DR severity per modified Davis staging
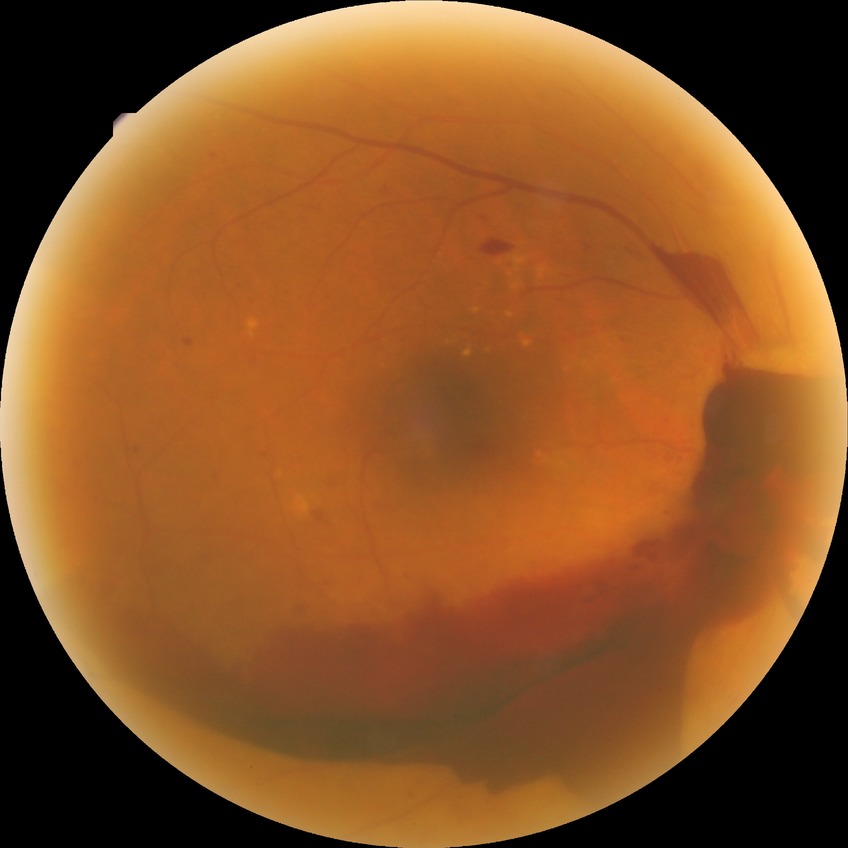 • diabetic retinopathy (DR): proliferative diabetic retinopathy (PDR)